CFP
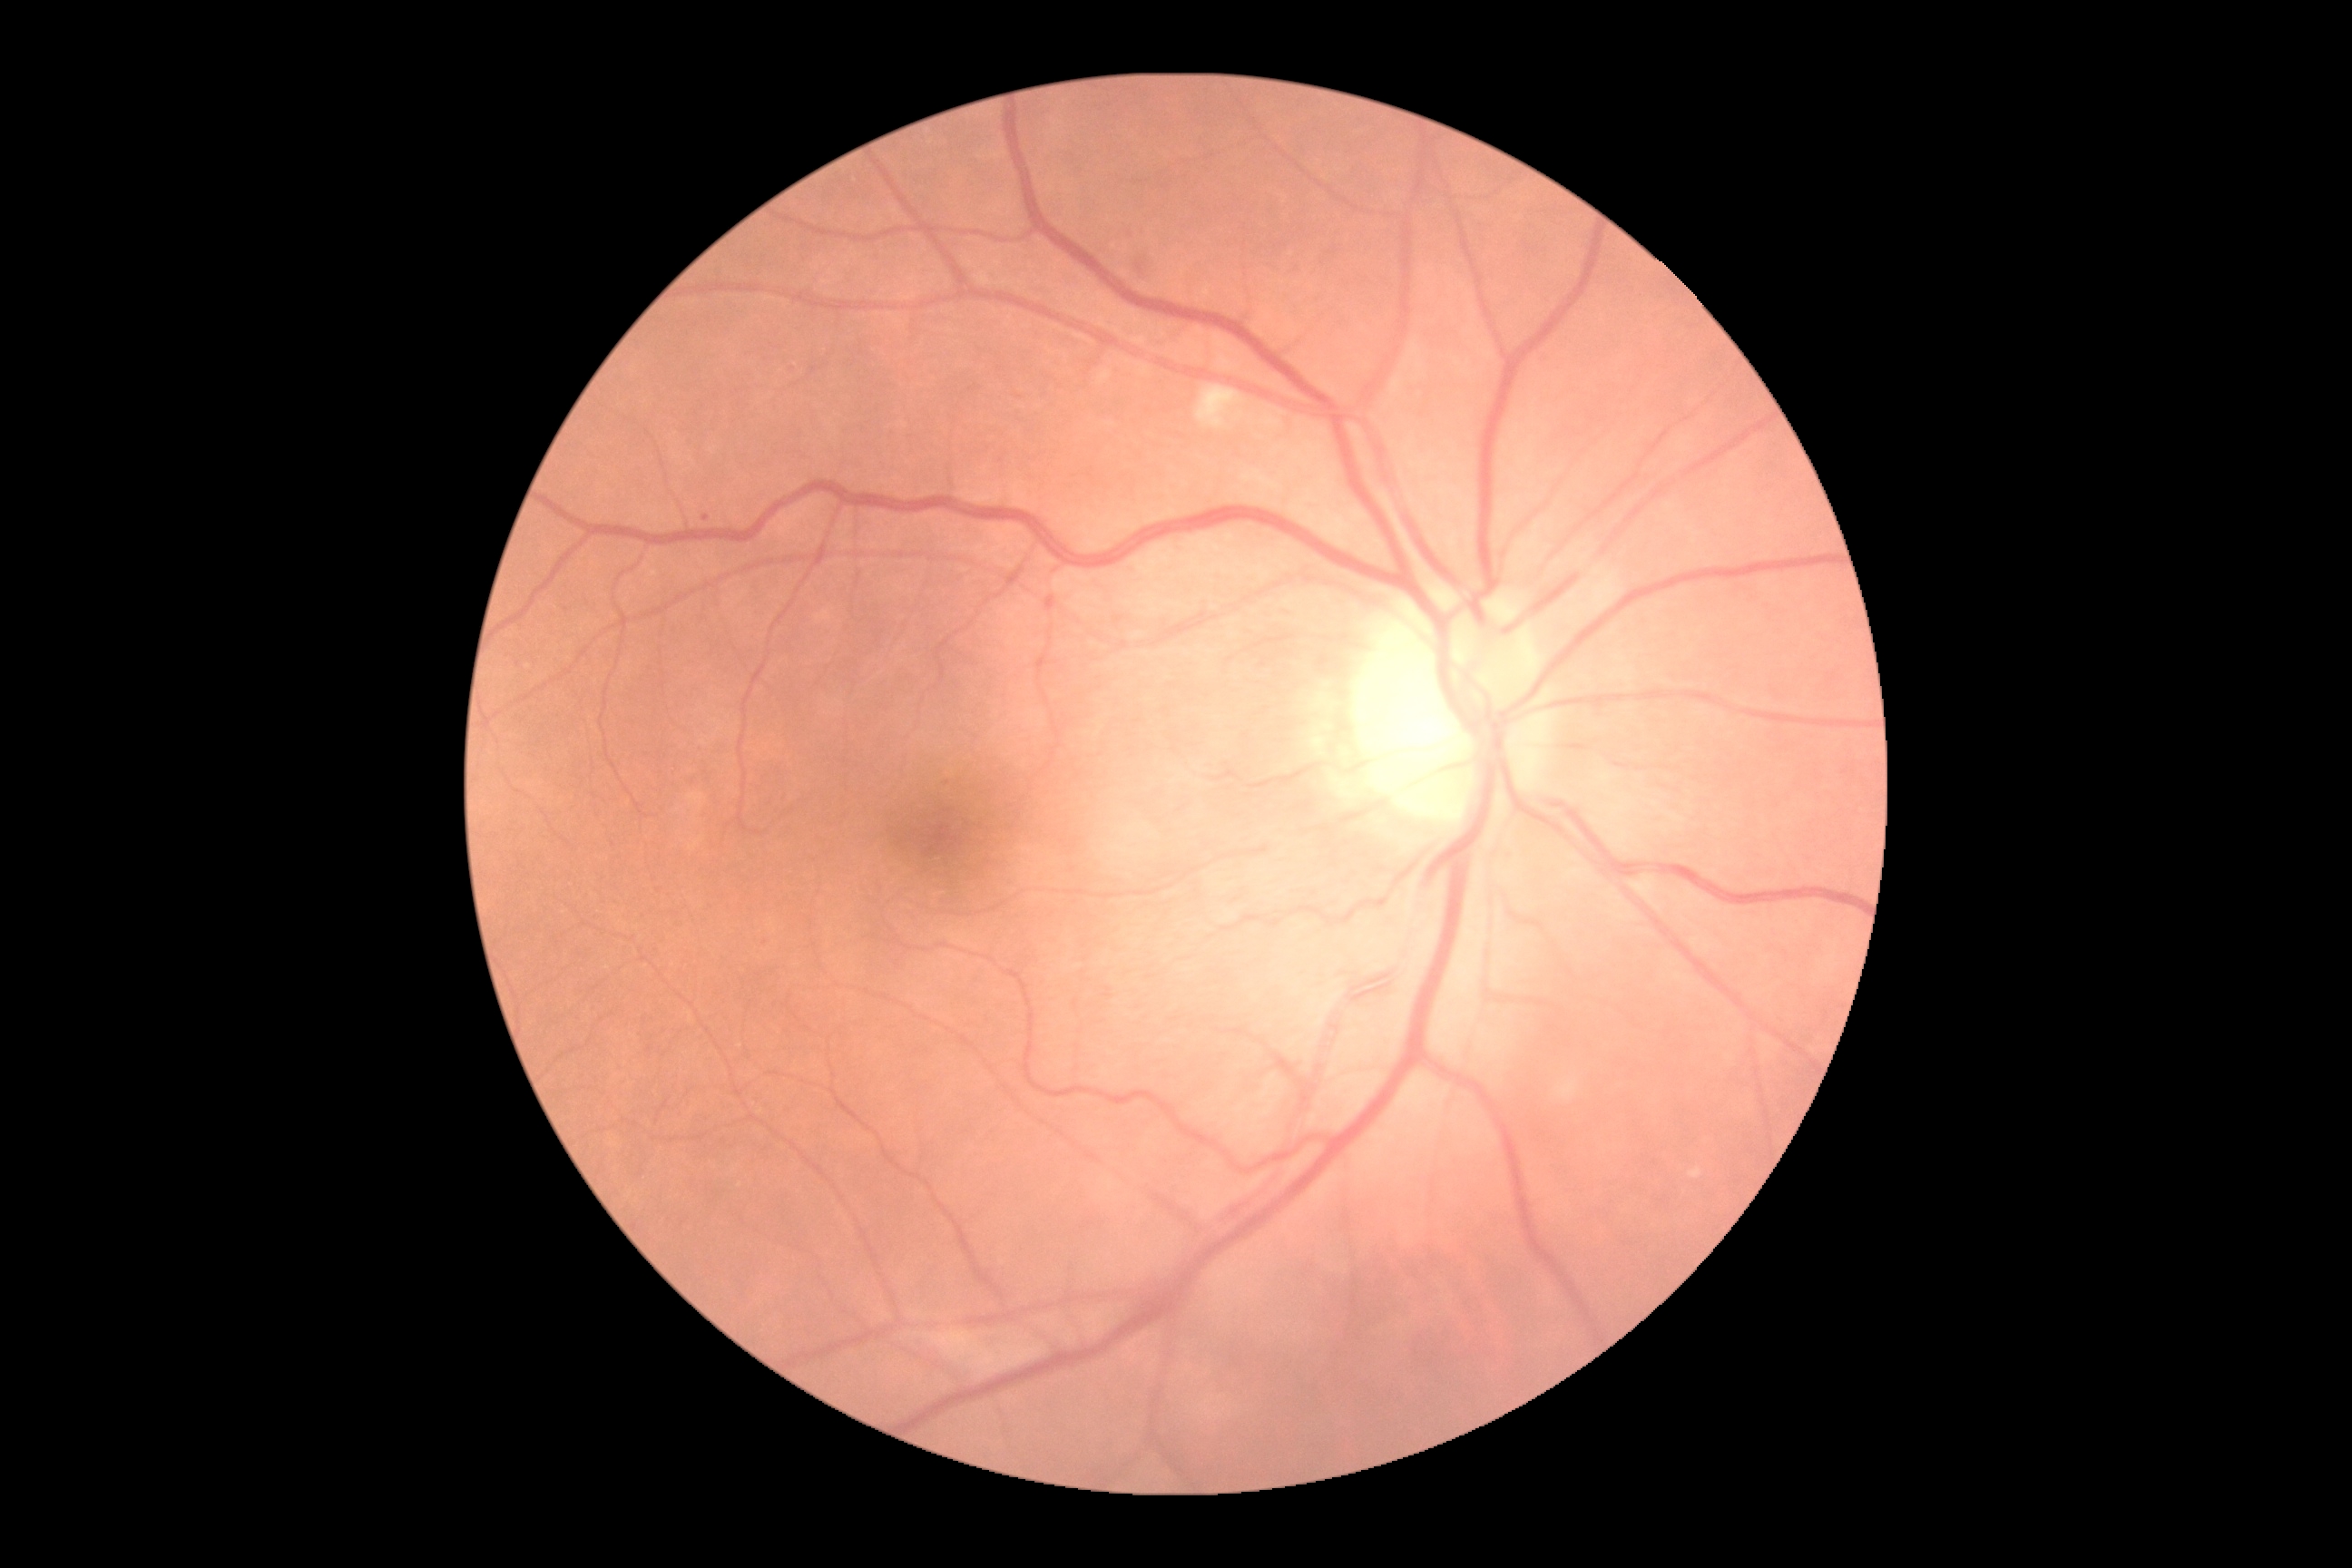 DR grade is 2.